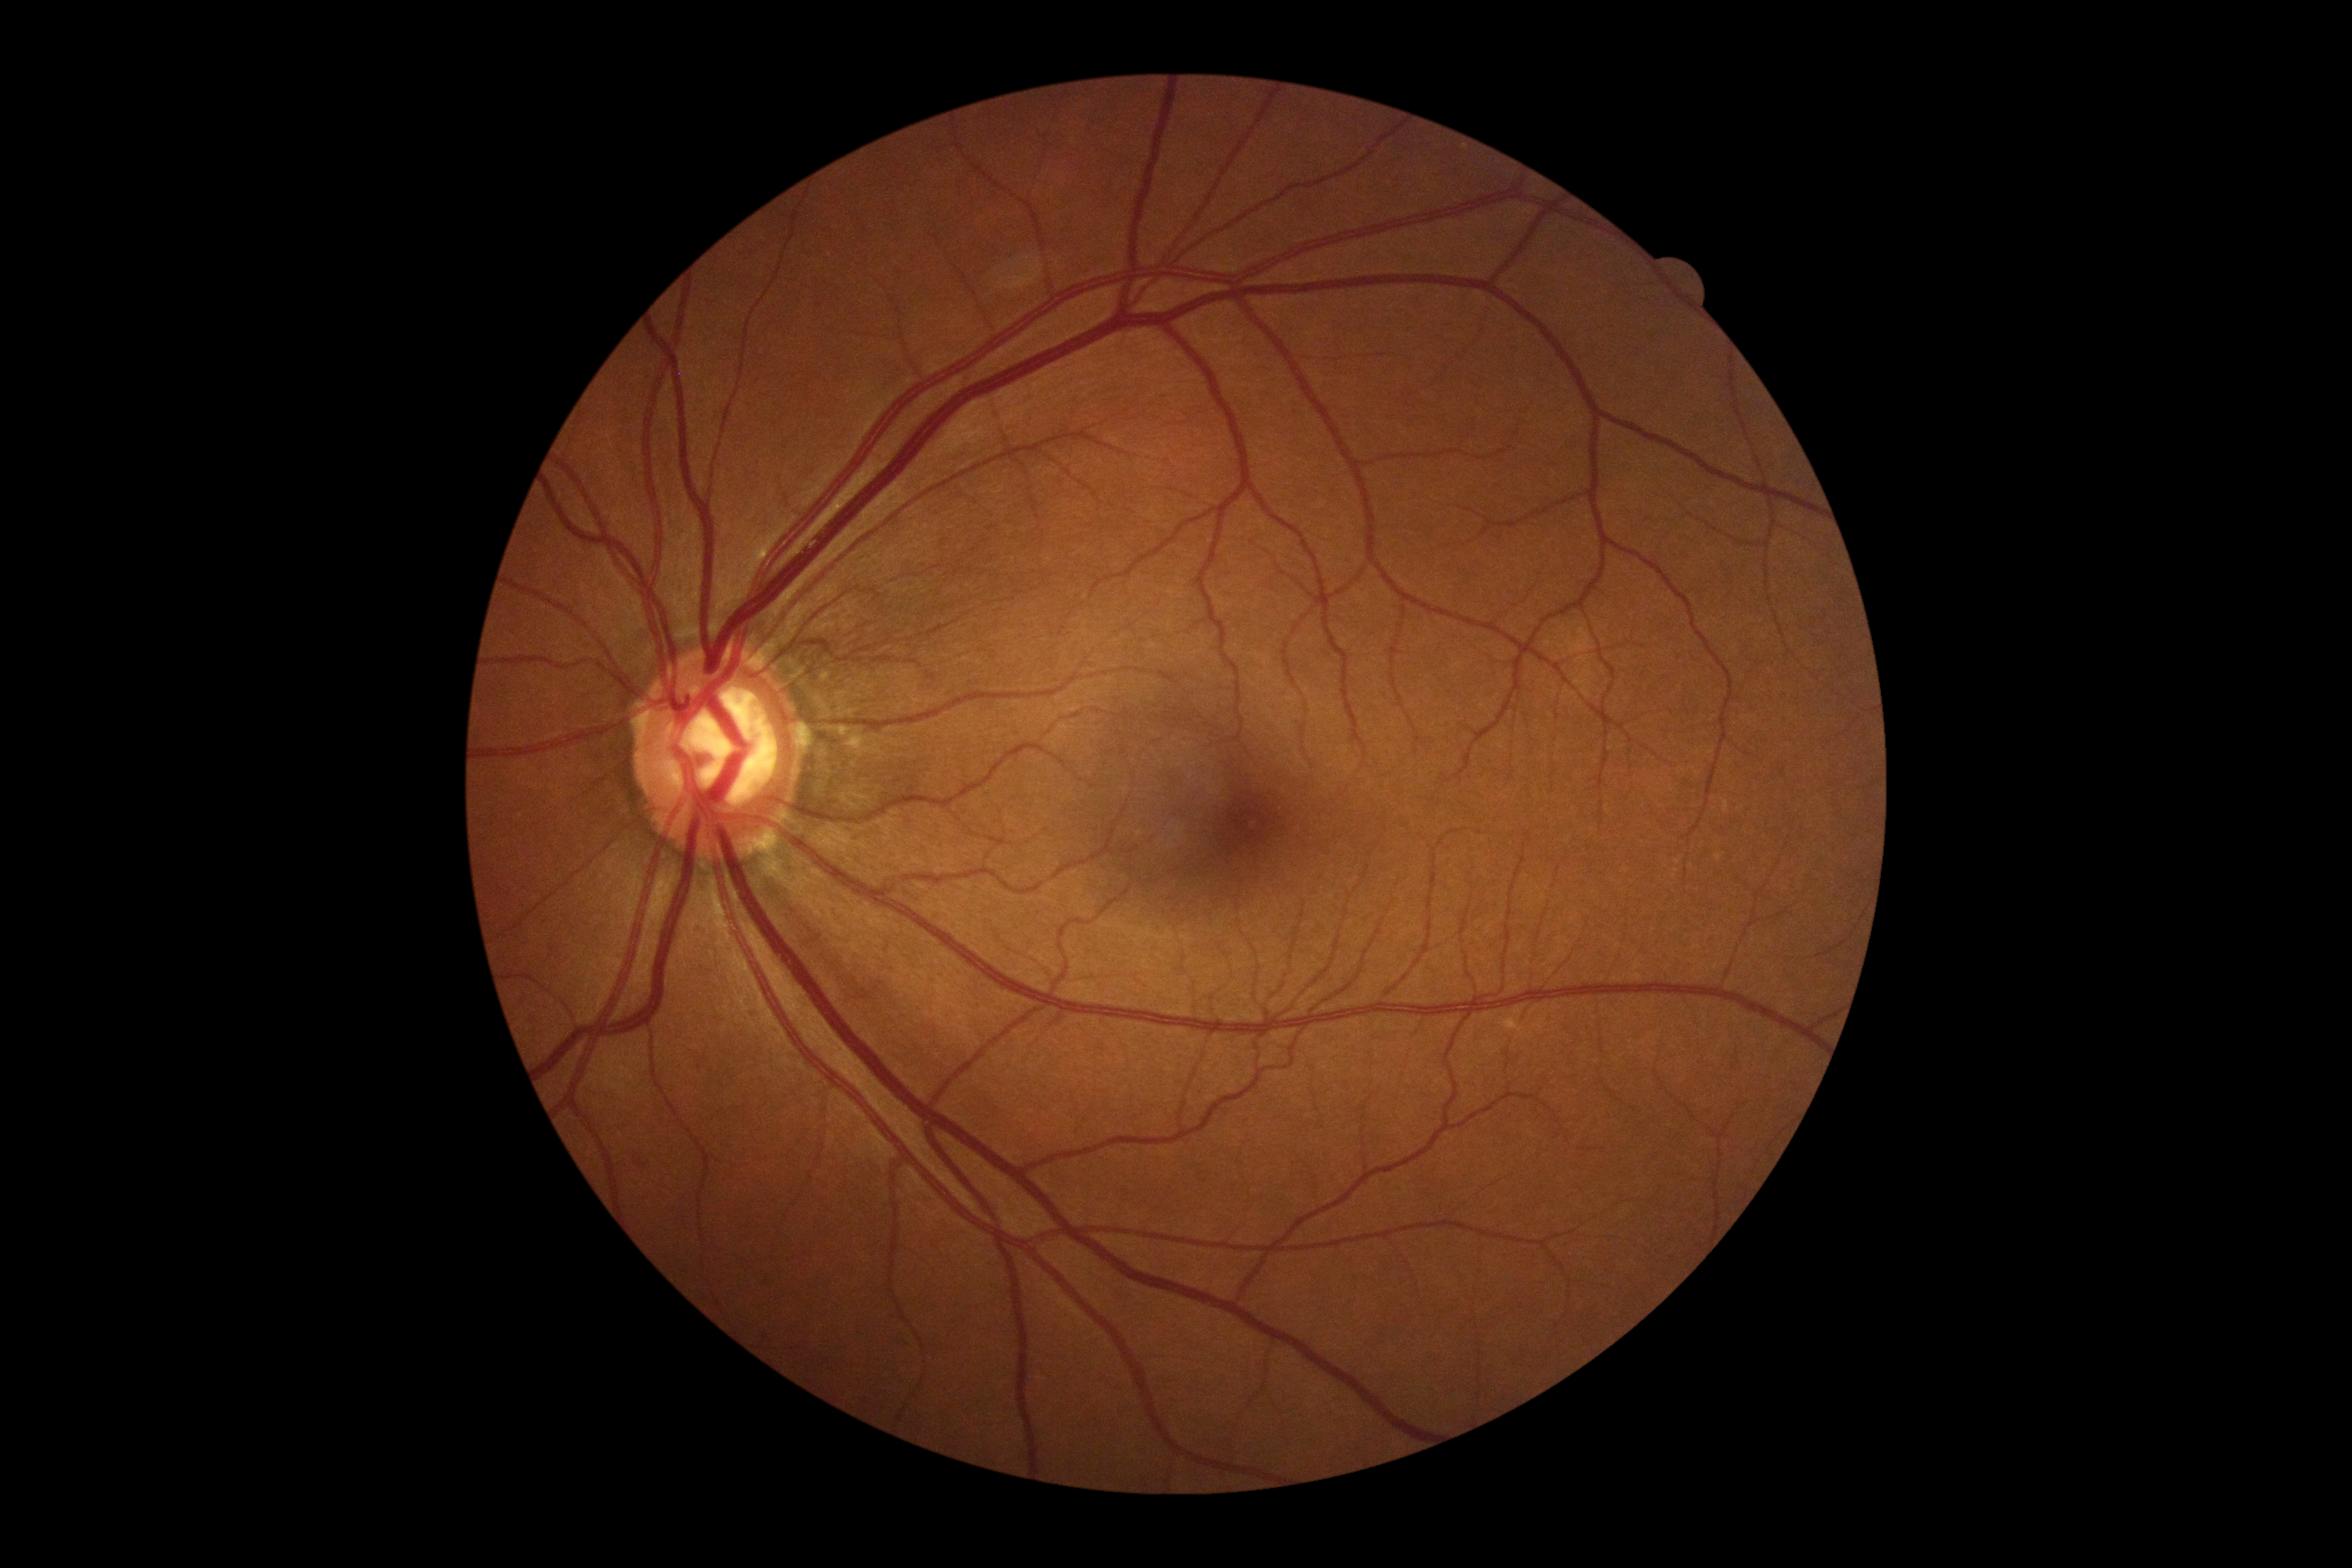

Retinopathy grade: 0/4.
No DR findings.